2184 x 1690 pixels:
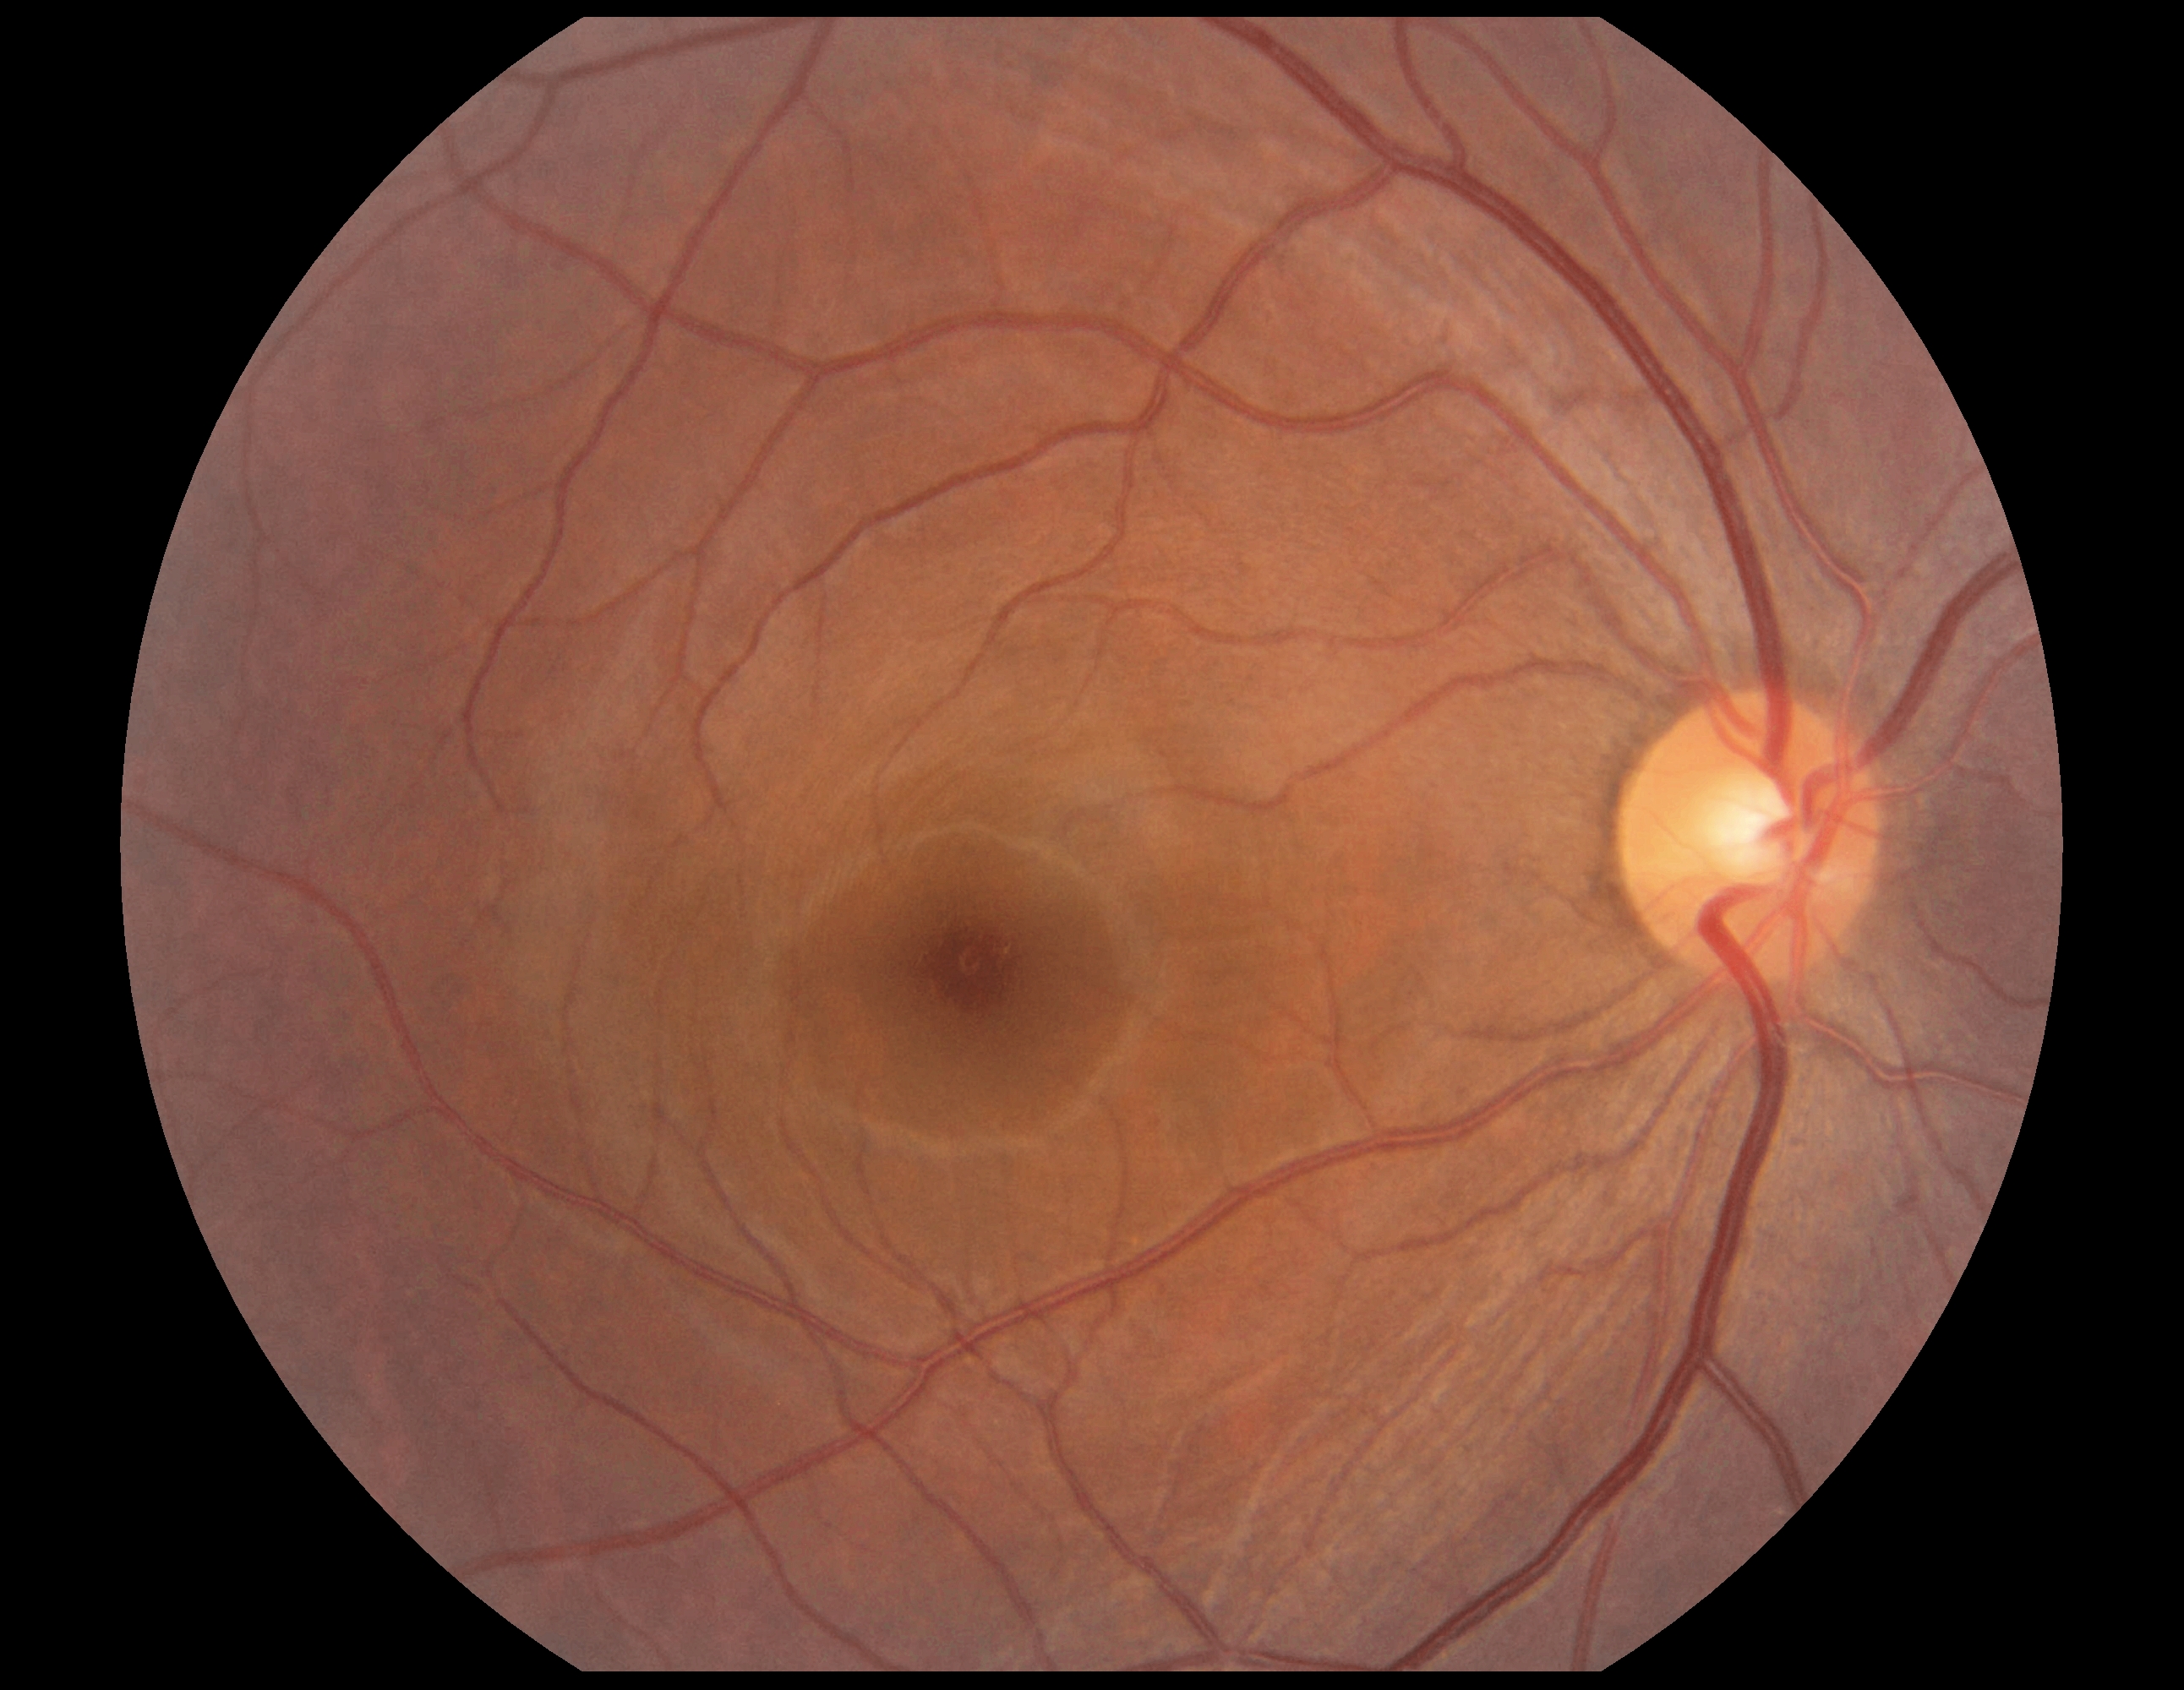   dr_impression: no DR findings
  dr_grade: grade 0